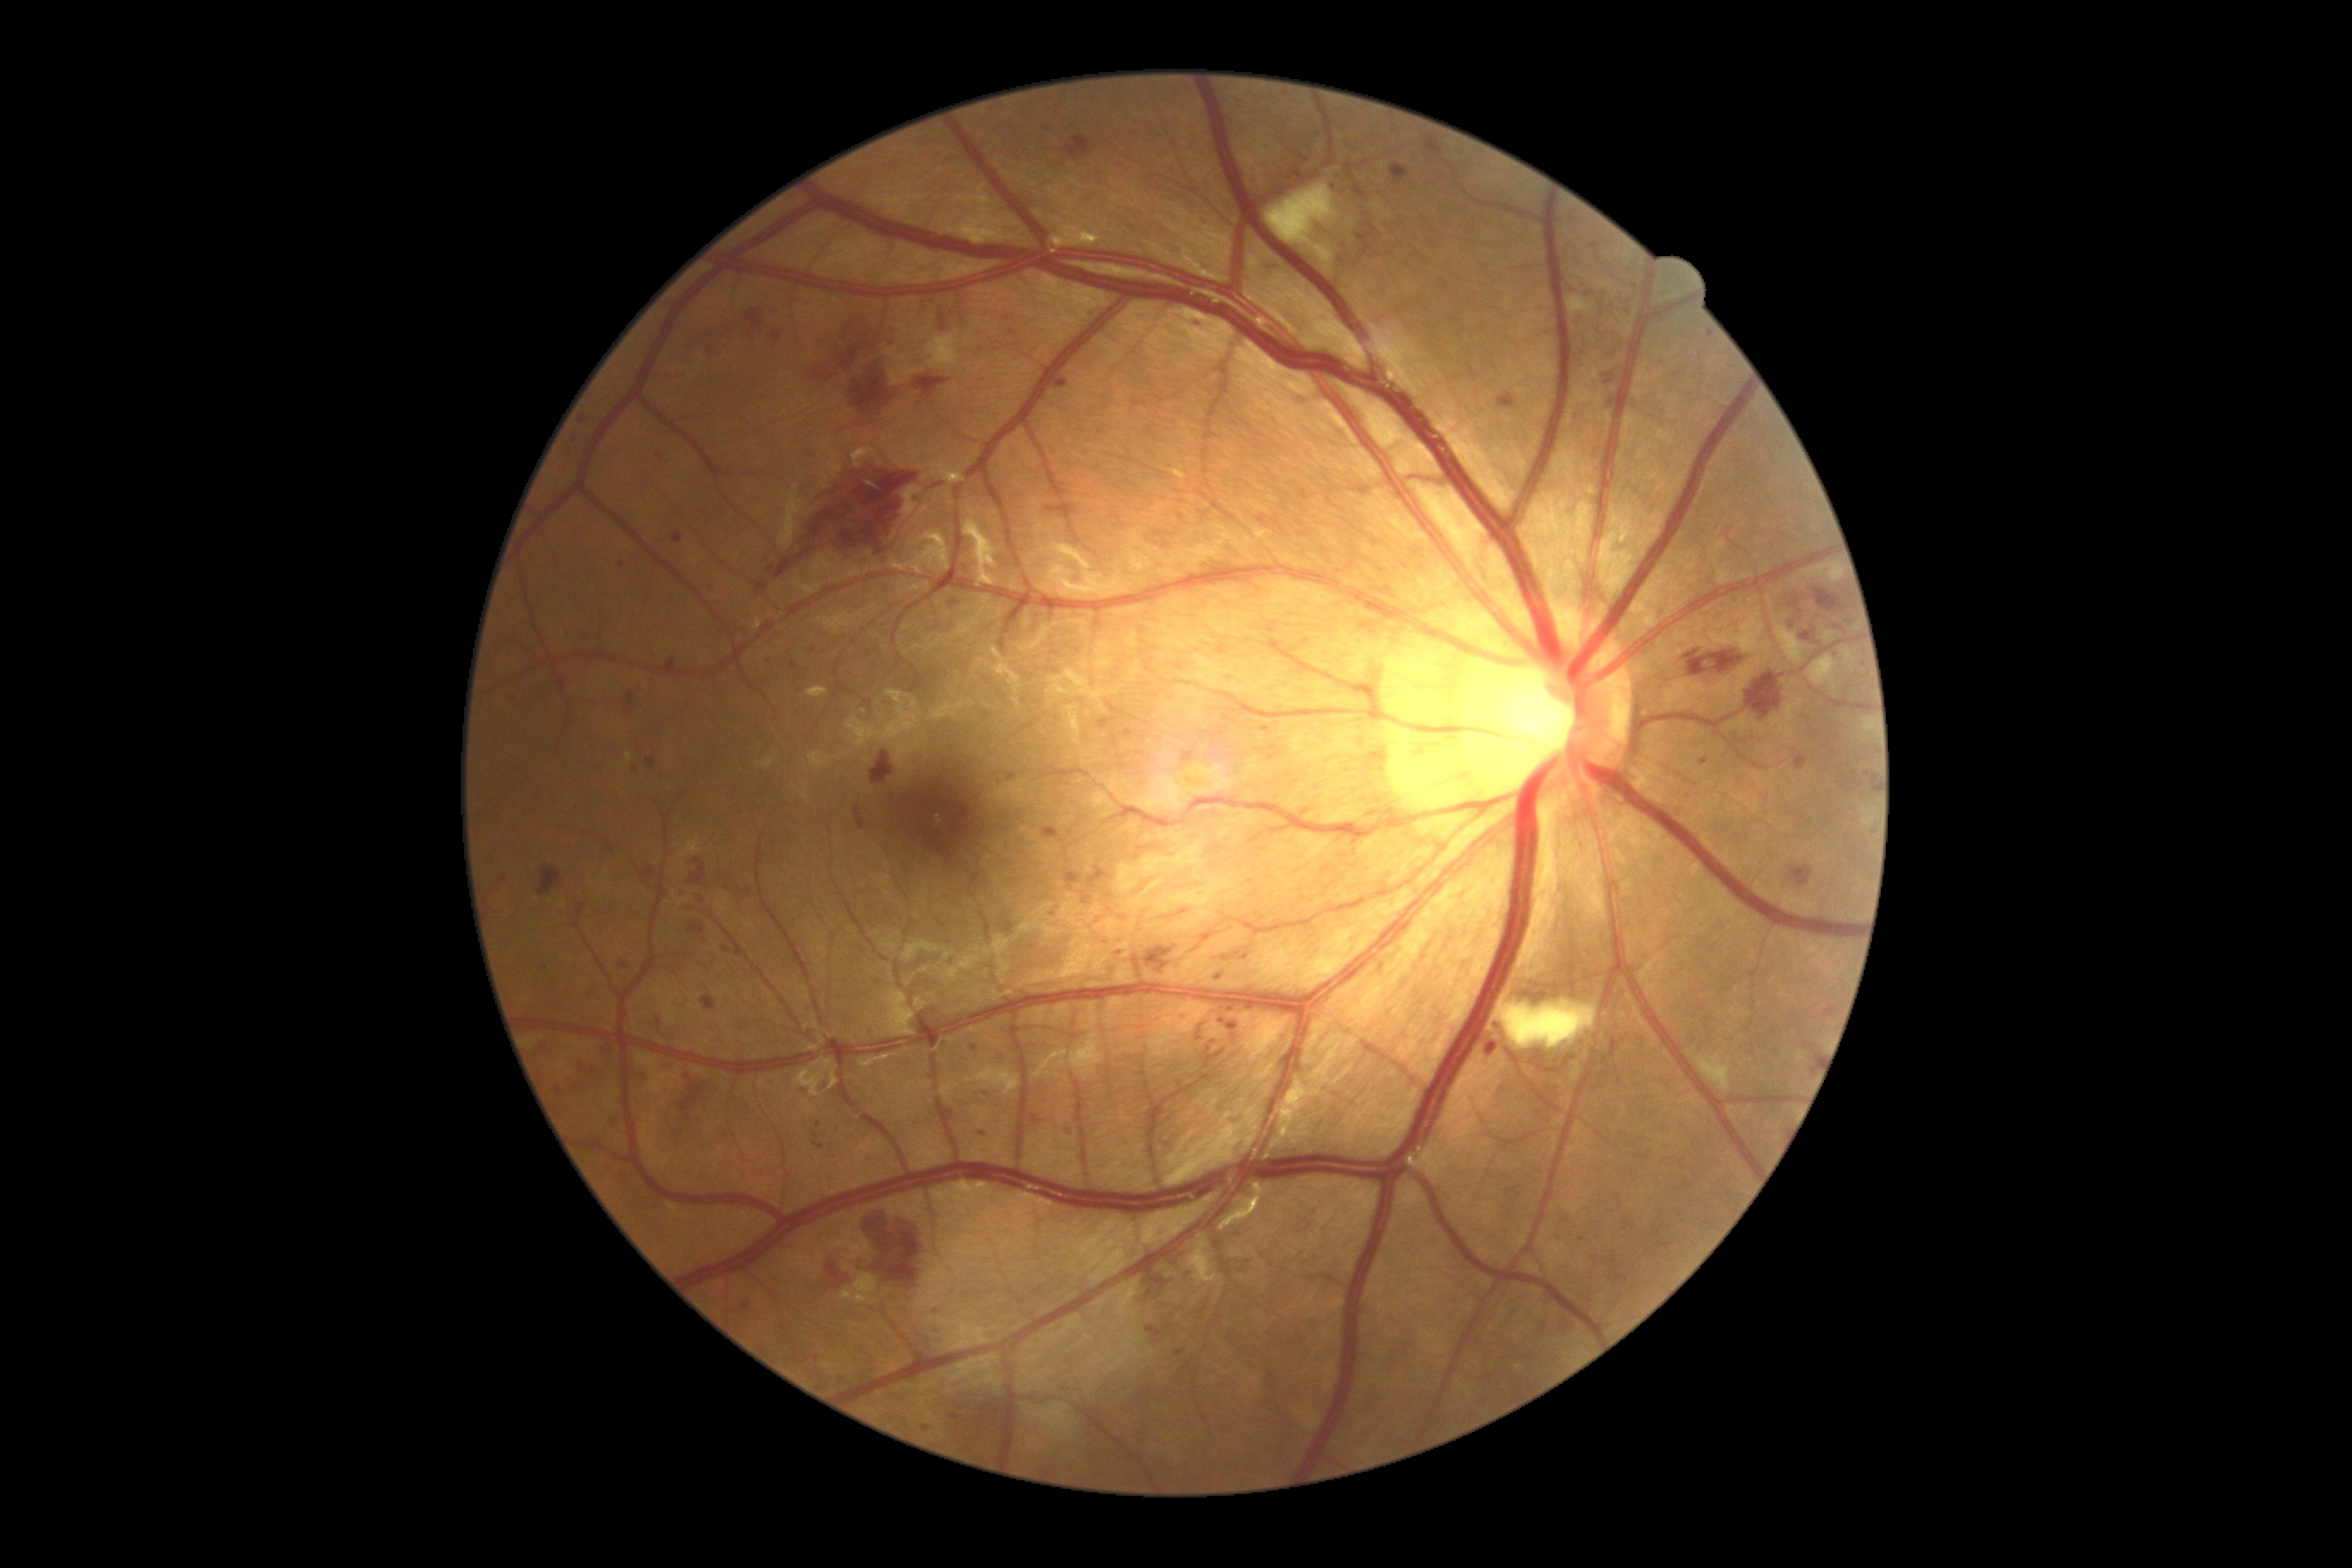
partial: true
dr_grade: 3
lesions:
  he:
    - 1287, 169, 1301, 181
    - 1148, 1326, 1163, 1344
    - 1823, 1008, 1837, 1017
    - 1175, 1351, 1184, 1357
    - 854, 807, 867, 830
    - 771, 329, 783, 341
    - 623, 692, 640, 716
    - 1067, 874, 1082, 885
    - 1794, 756, 1808, 771
    - 838, 314, 874, 355
    - 859, 1210, 926, 1290
    - 740, 1022, 749, 1031
    - 891, 384, 912, 401
    - 756, 582, 769, 596
    - 871, 752, 895, 785
    - 1357, 223, 1378, 257
    - 721, 881, 756, 897
  he_small:
    - (x=689, y=1120)
    - (x=728, y=331)
    - (x=1818, y=1059)
  ma:
    - 1125, 730, 1134, 737
    - 950, 1414, 962, 1423
    - 1067, 1125, 1070, 1137
    - 1701, 757, 1710, 766
    - 1486, 1043, 1498, 1057
    - 656, 453, 665, 460
    - 1220, 1019, 1237, 1031
    - 933, 1308, 945, 1314
    - 792, 663, 800, 670
  ma_small:
    - (x=813, y=651)
    - (x=1710, y=335)
    - (x=622, y=564)
    - (x=1231, y=1011)
    - (x=583, y=420)
    - (x=819, y=1124)
    - (x=986, y=1095)